2048 x 1536 pixels: 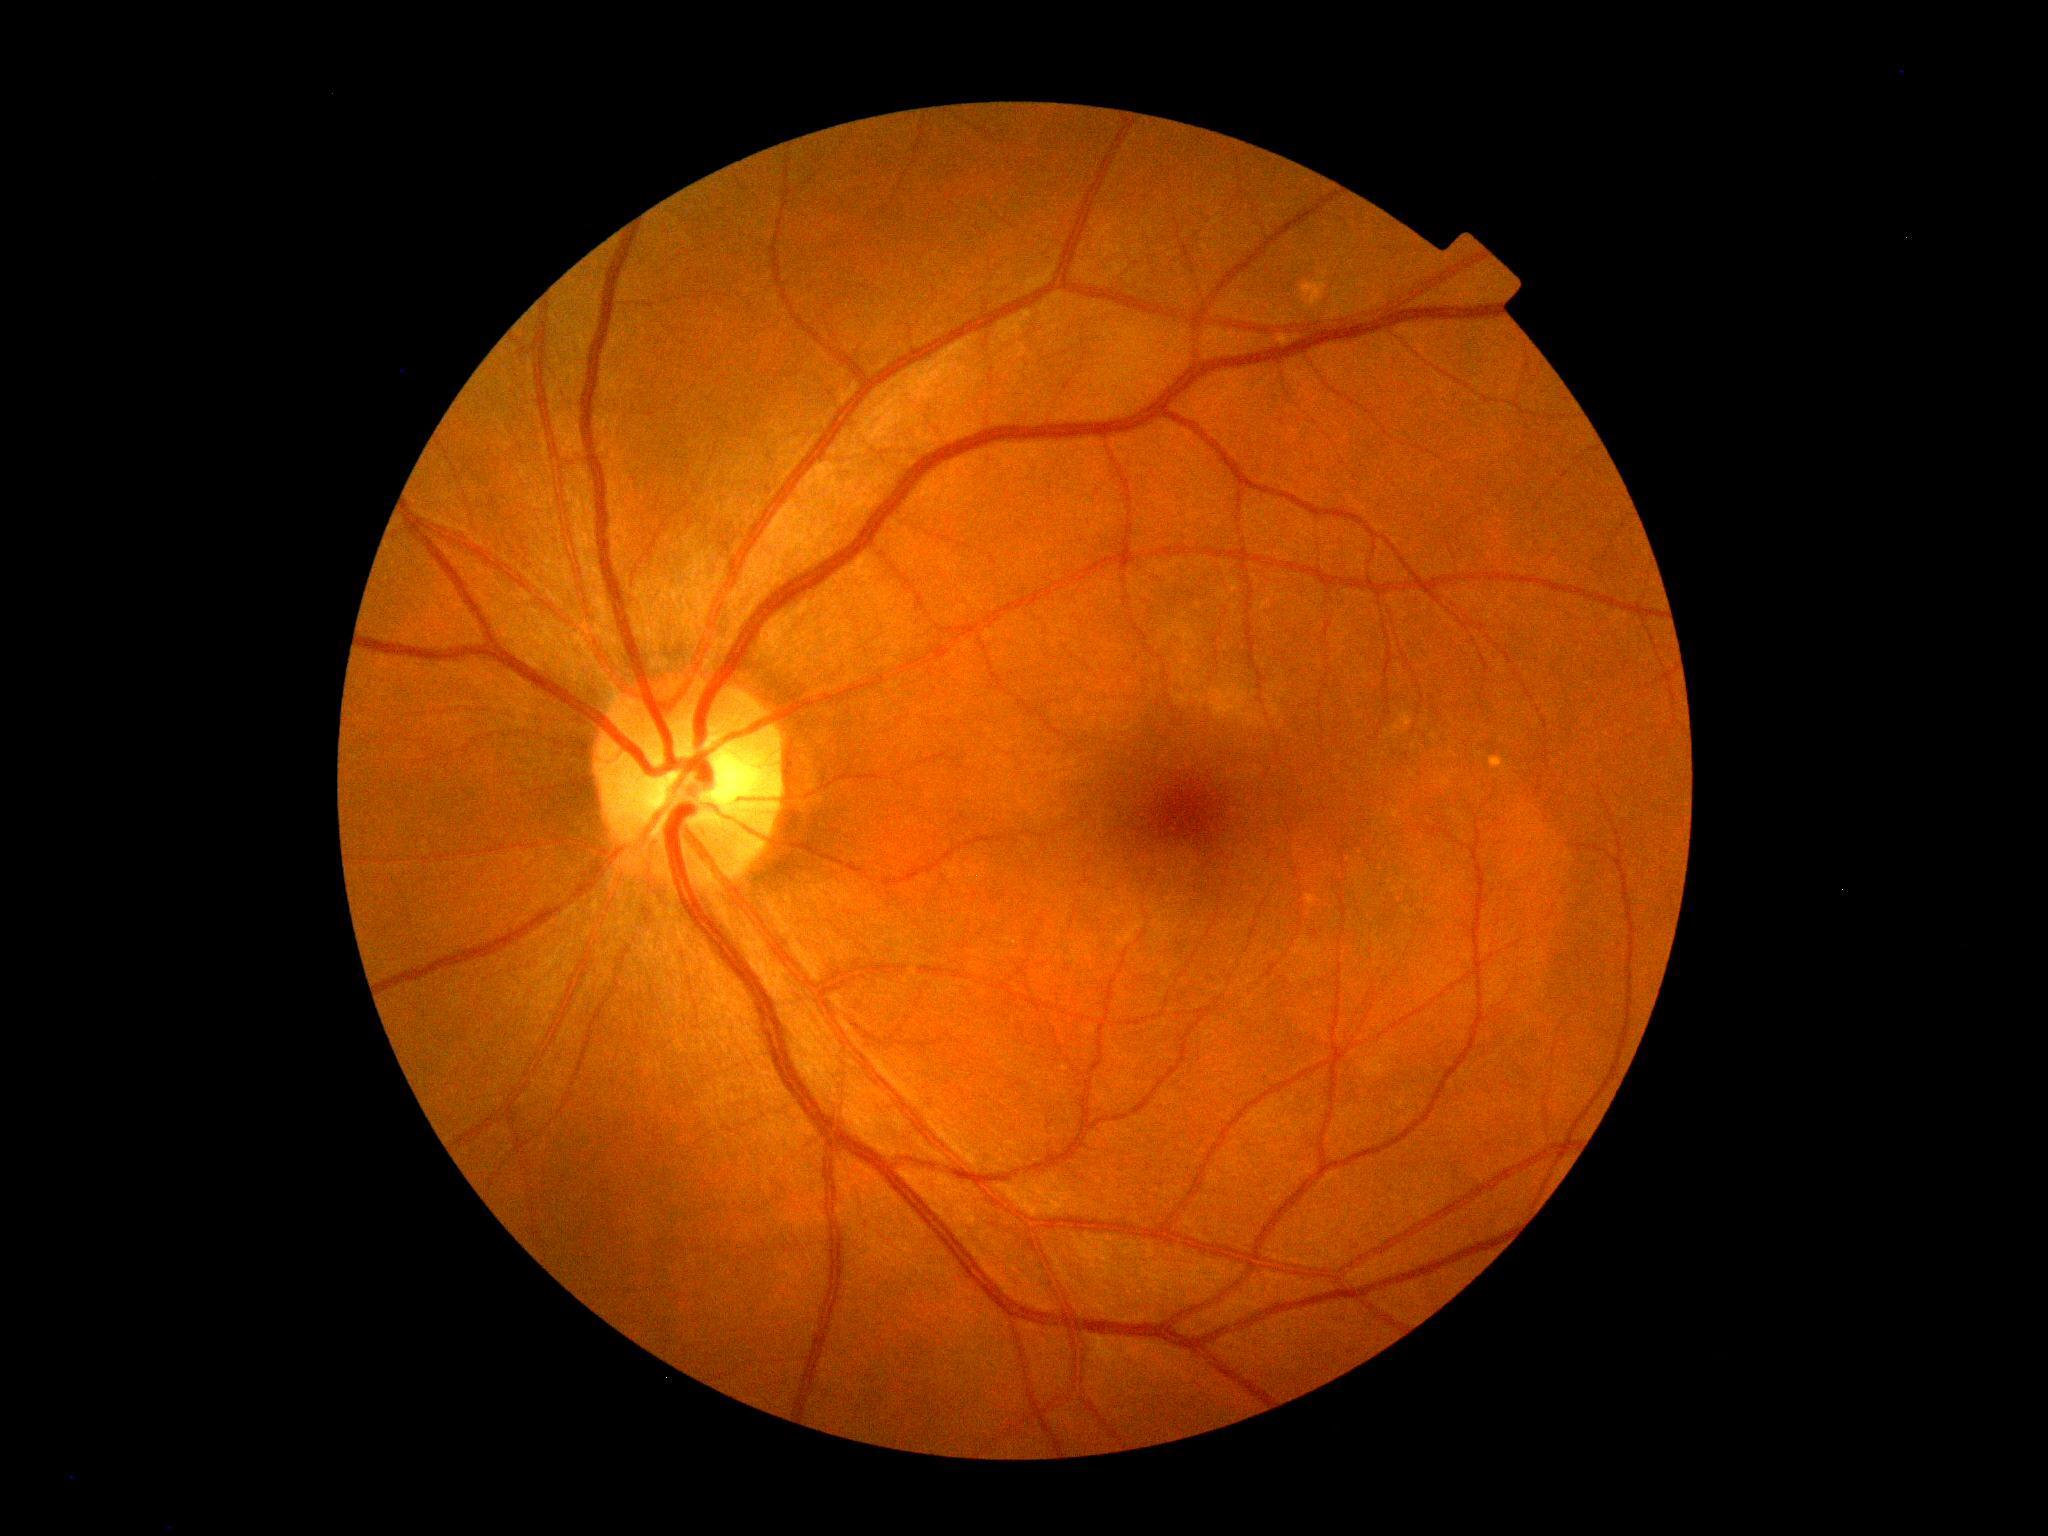 DR stage@grade 0 (no apparent retinopathy), DR impression@no DR findings.